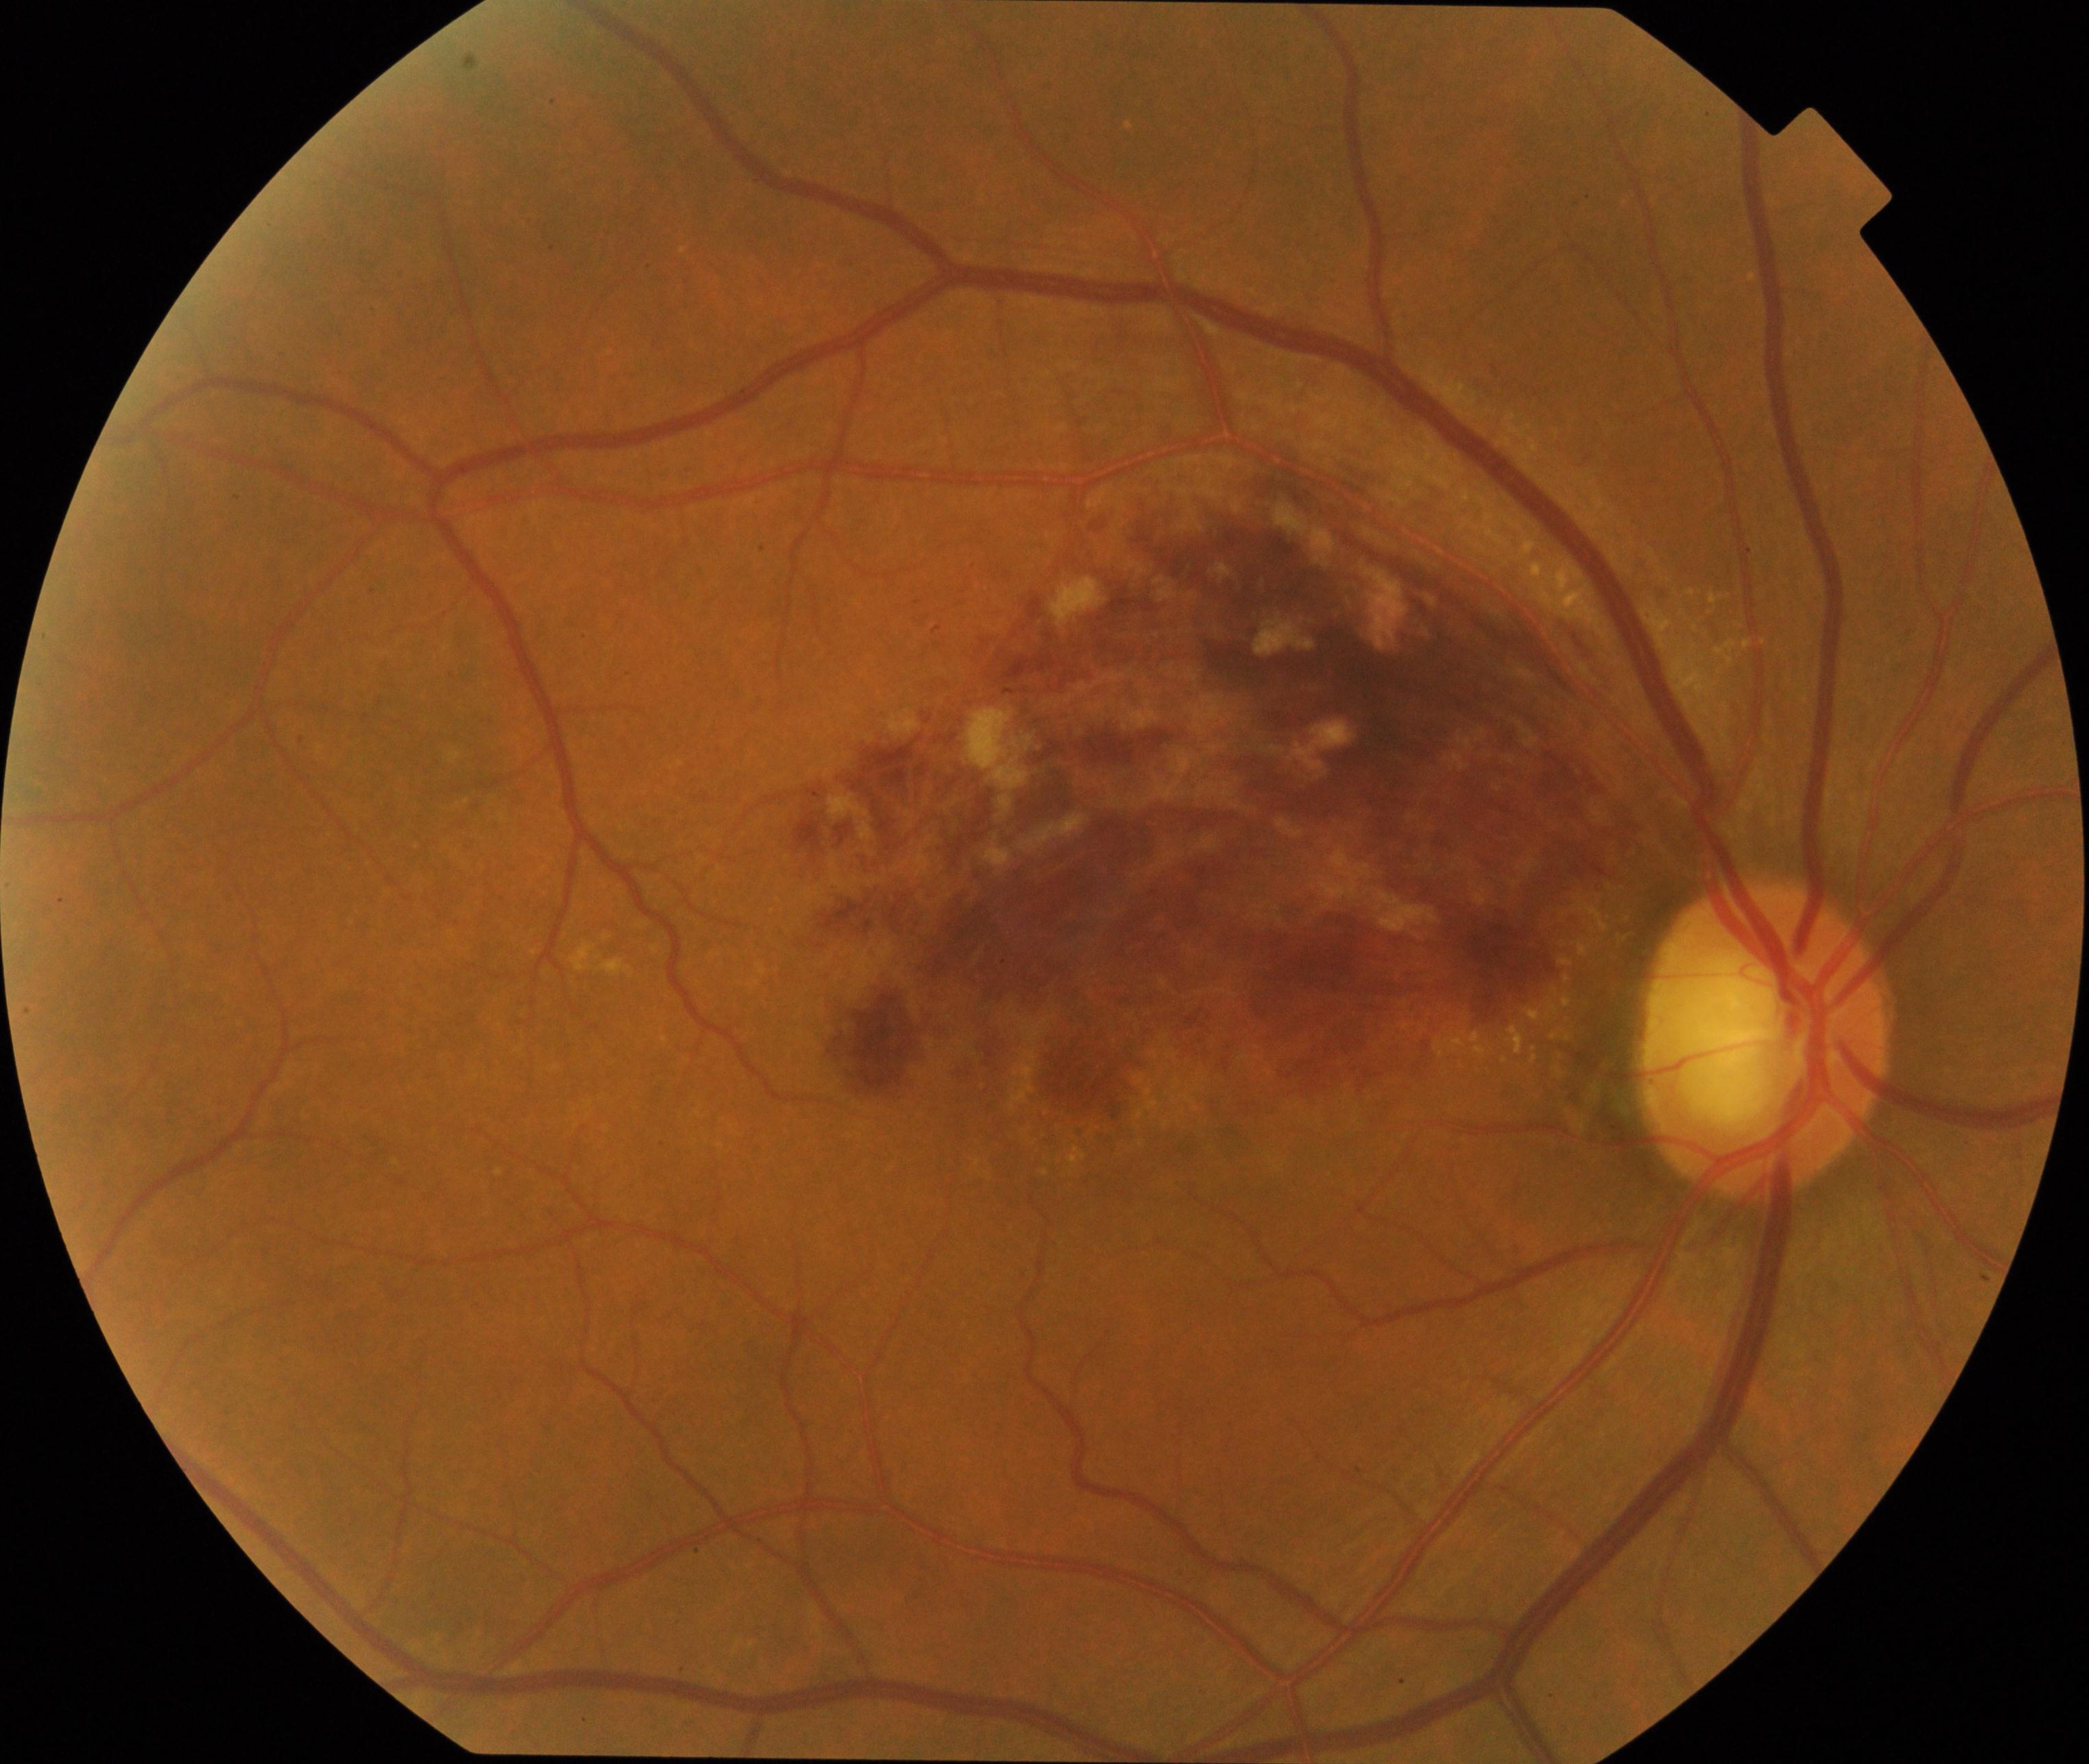 Diagnosis: branch retinal vein occlusion (BRVO).